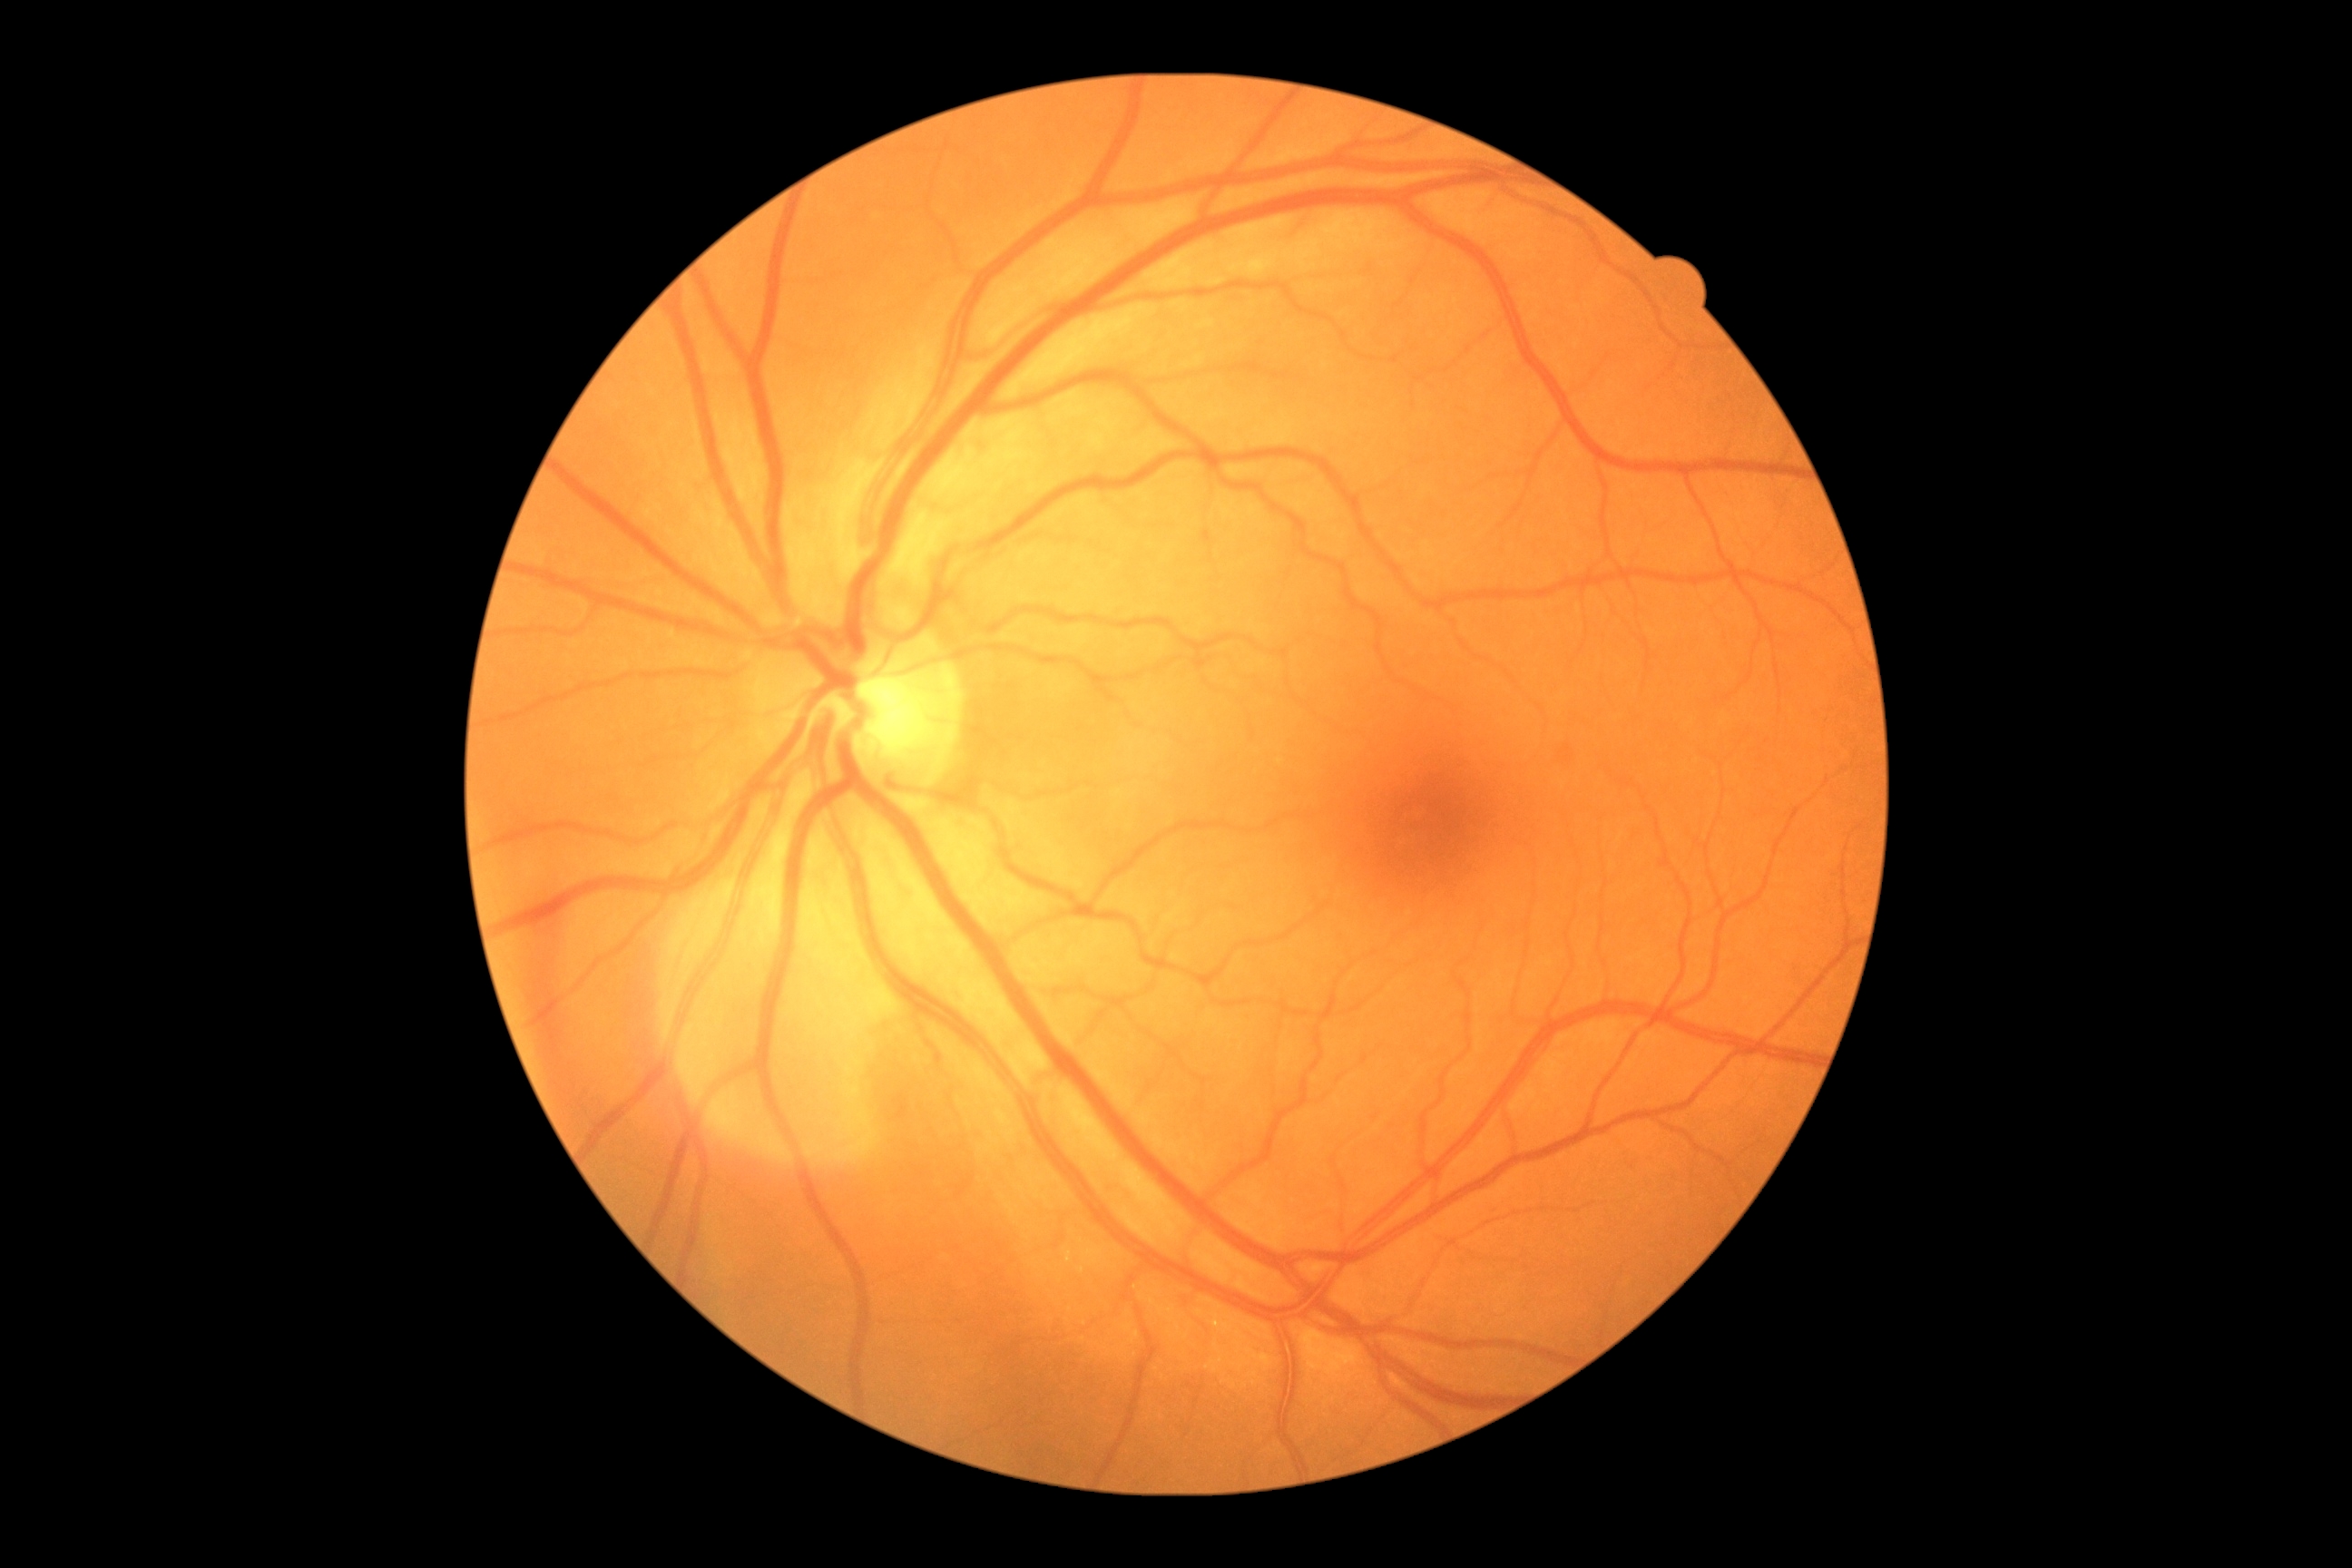

{
  "dr_grade": "0/4"
}